Wide-field fundus image from infant ROP screening; 640x480
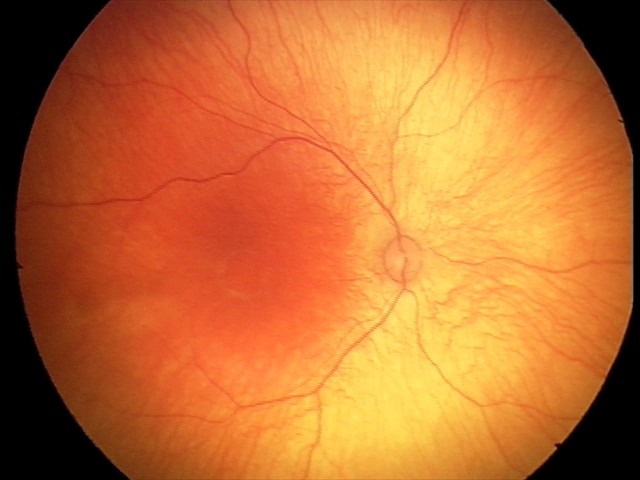

No retinal pathology identified on screening.